Fundus photo, 2089x1764px: 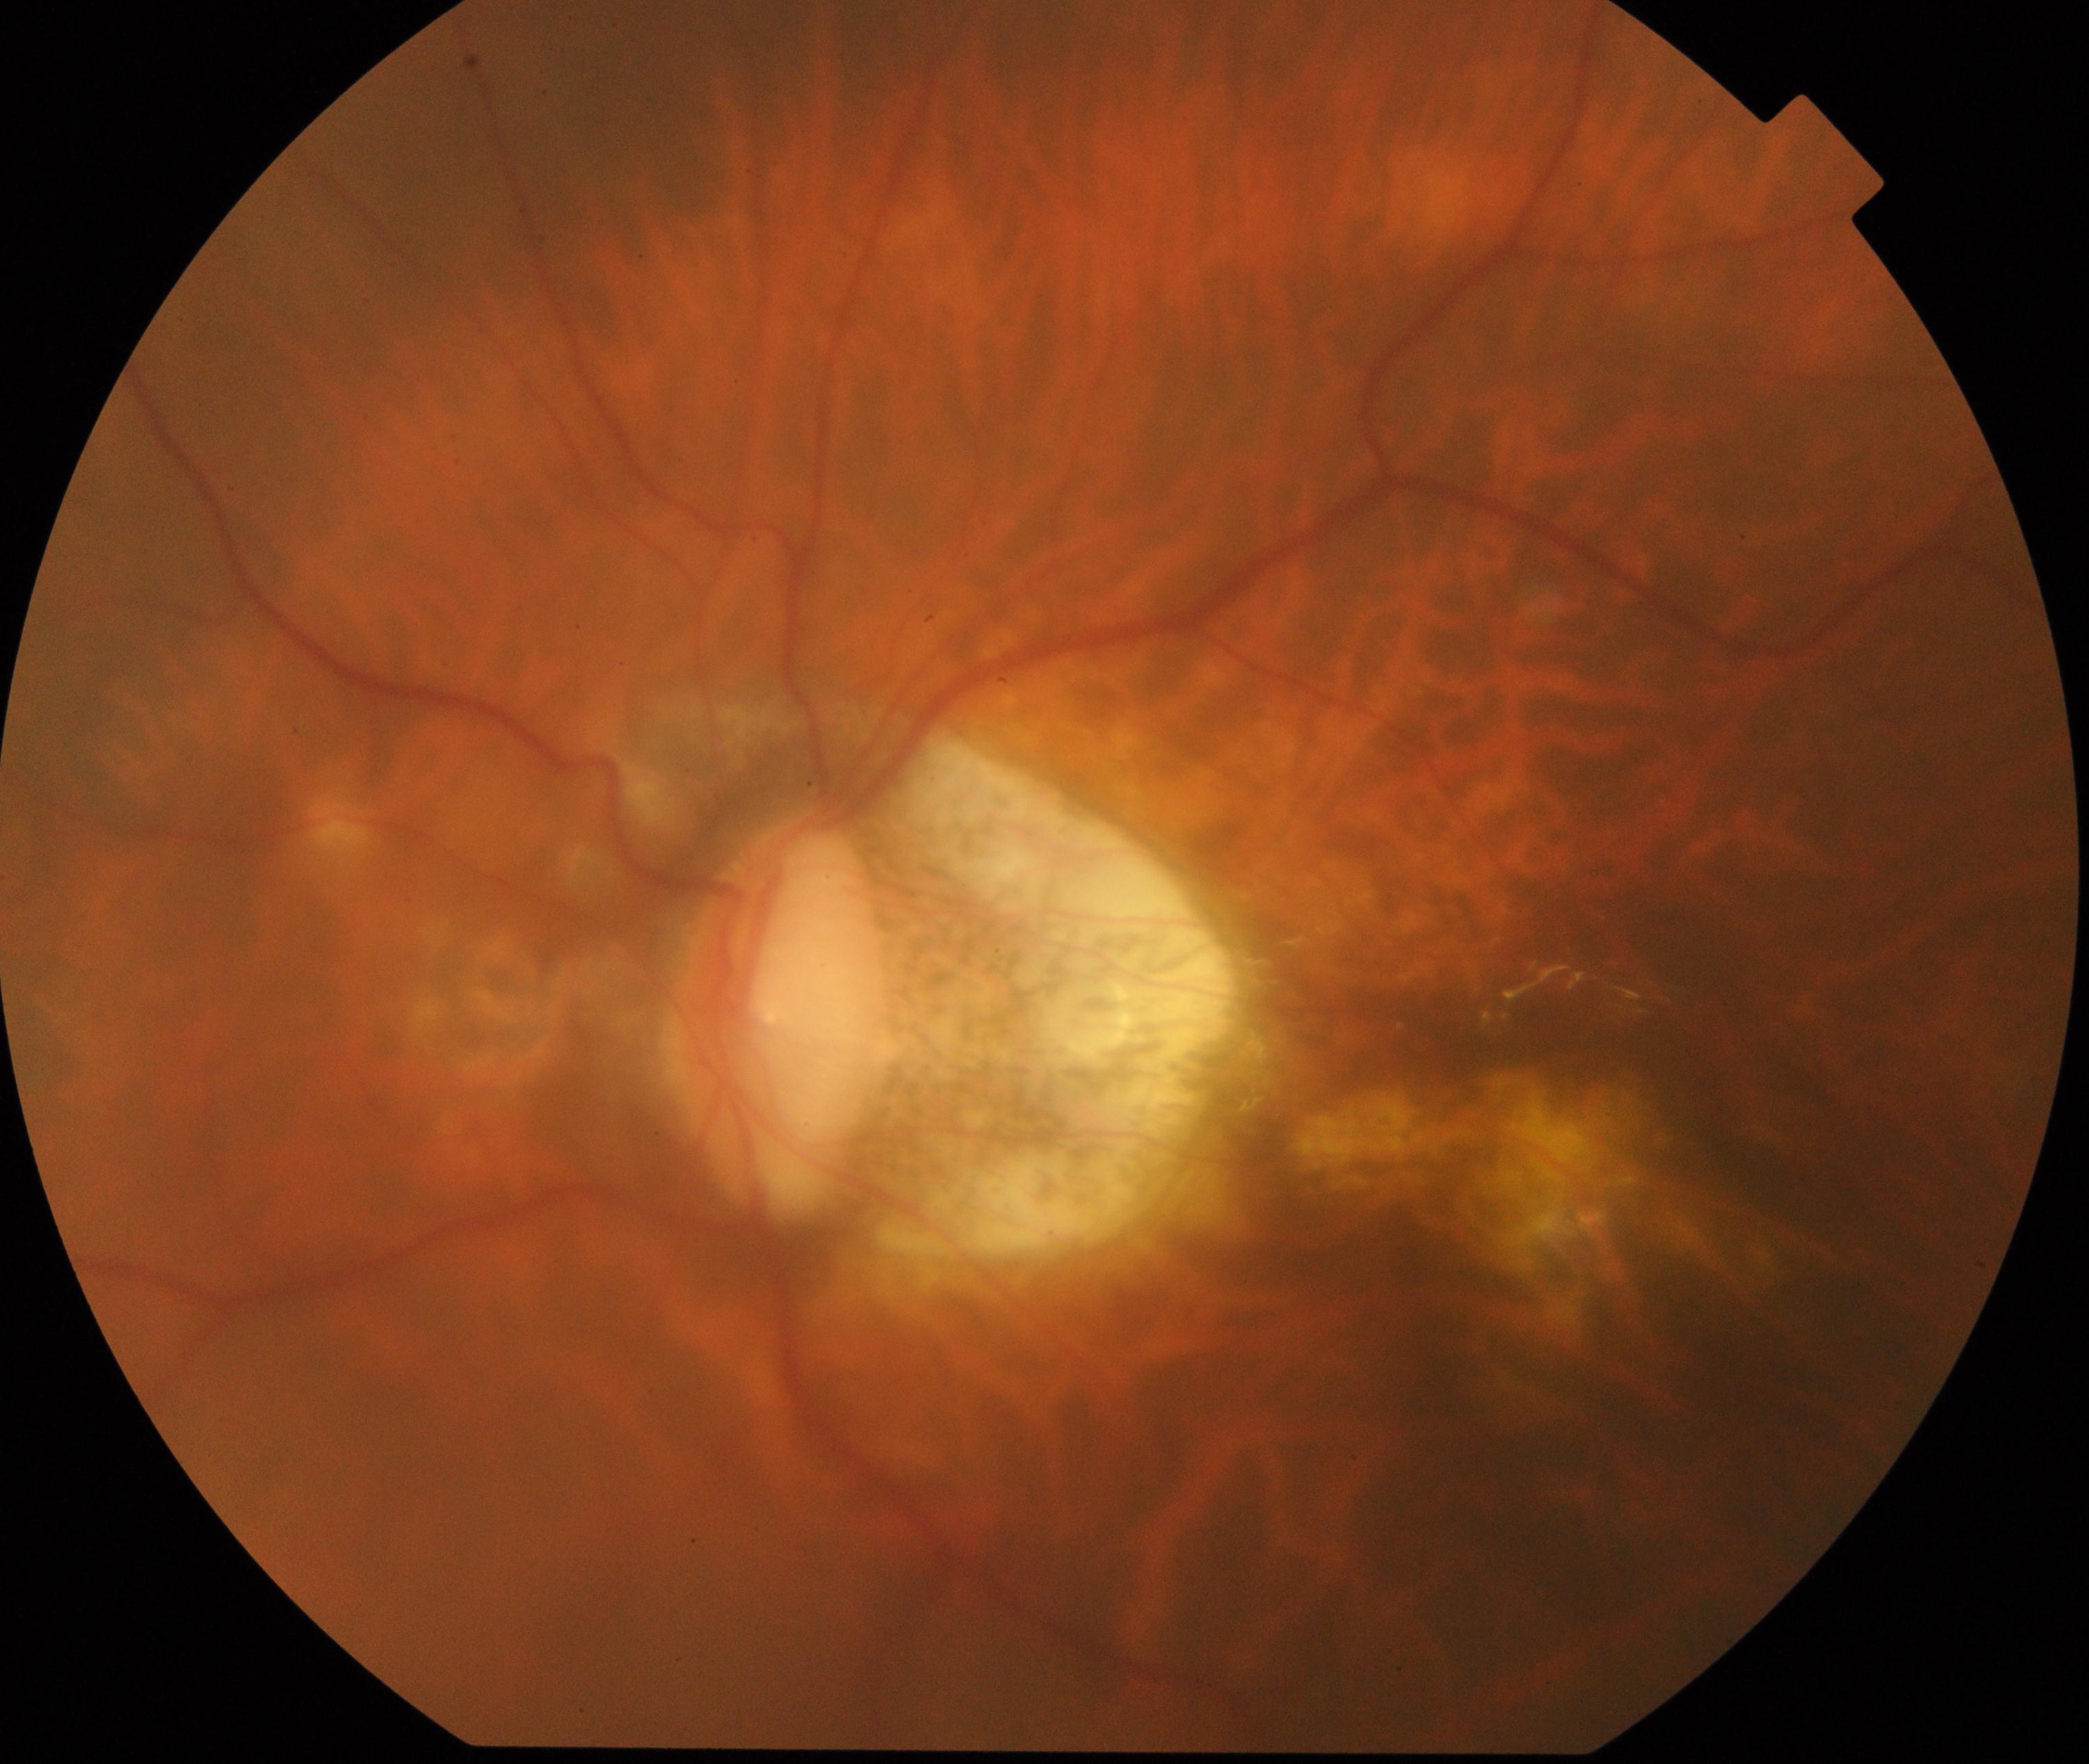

Impression: pathological myopia.